2089x1764px. Fundus photo:
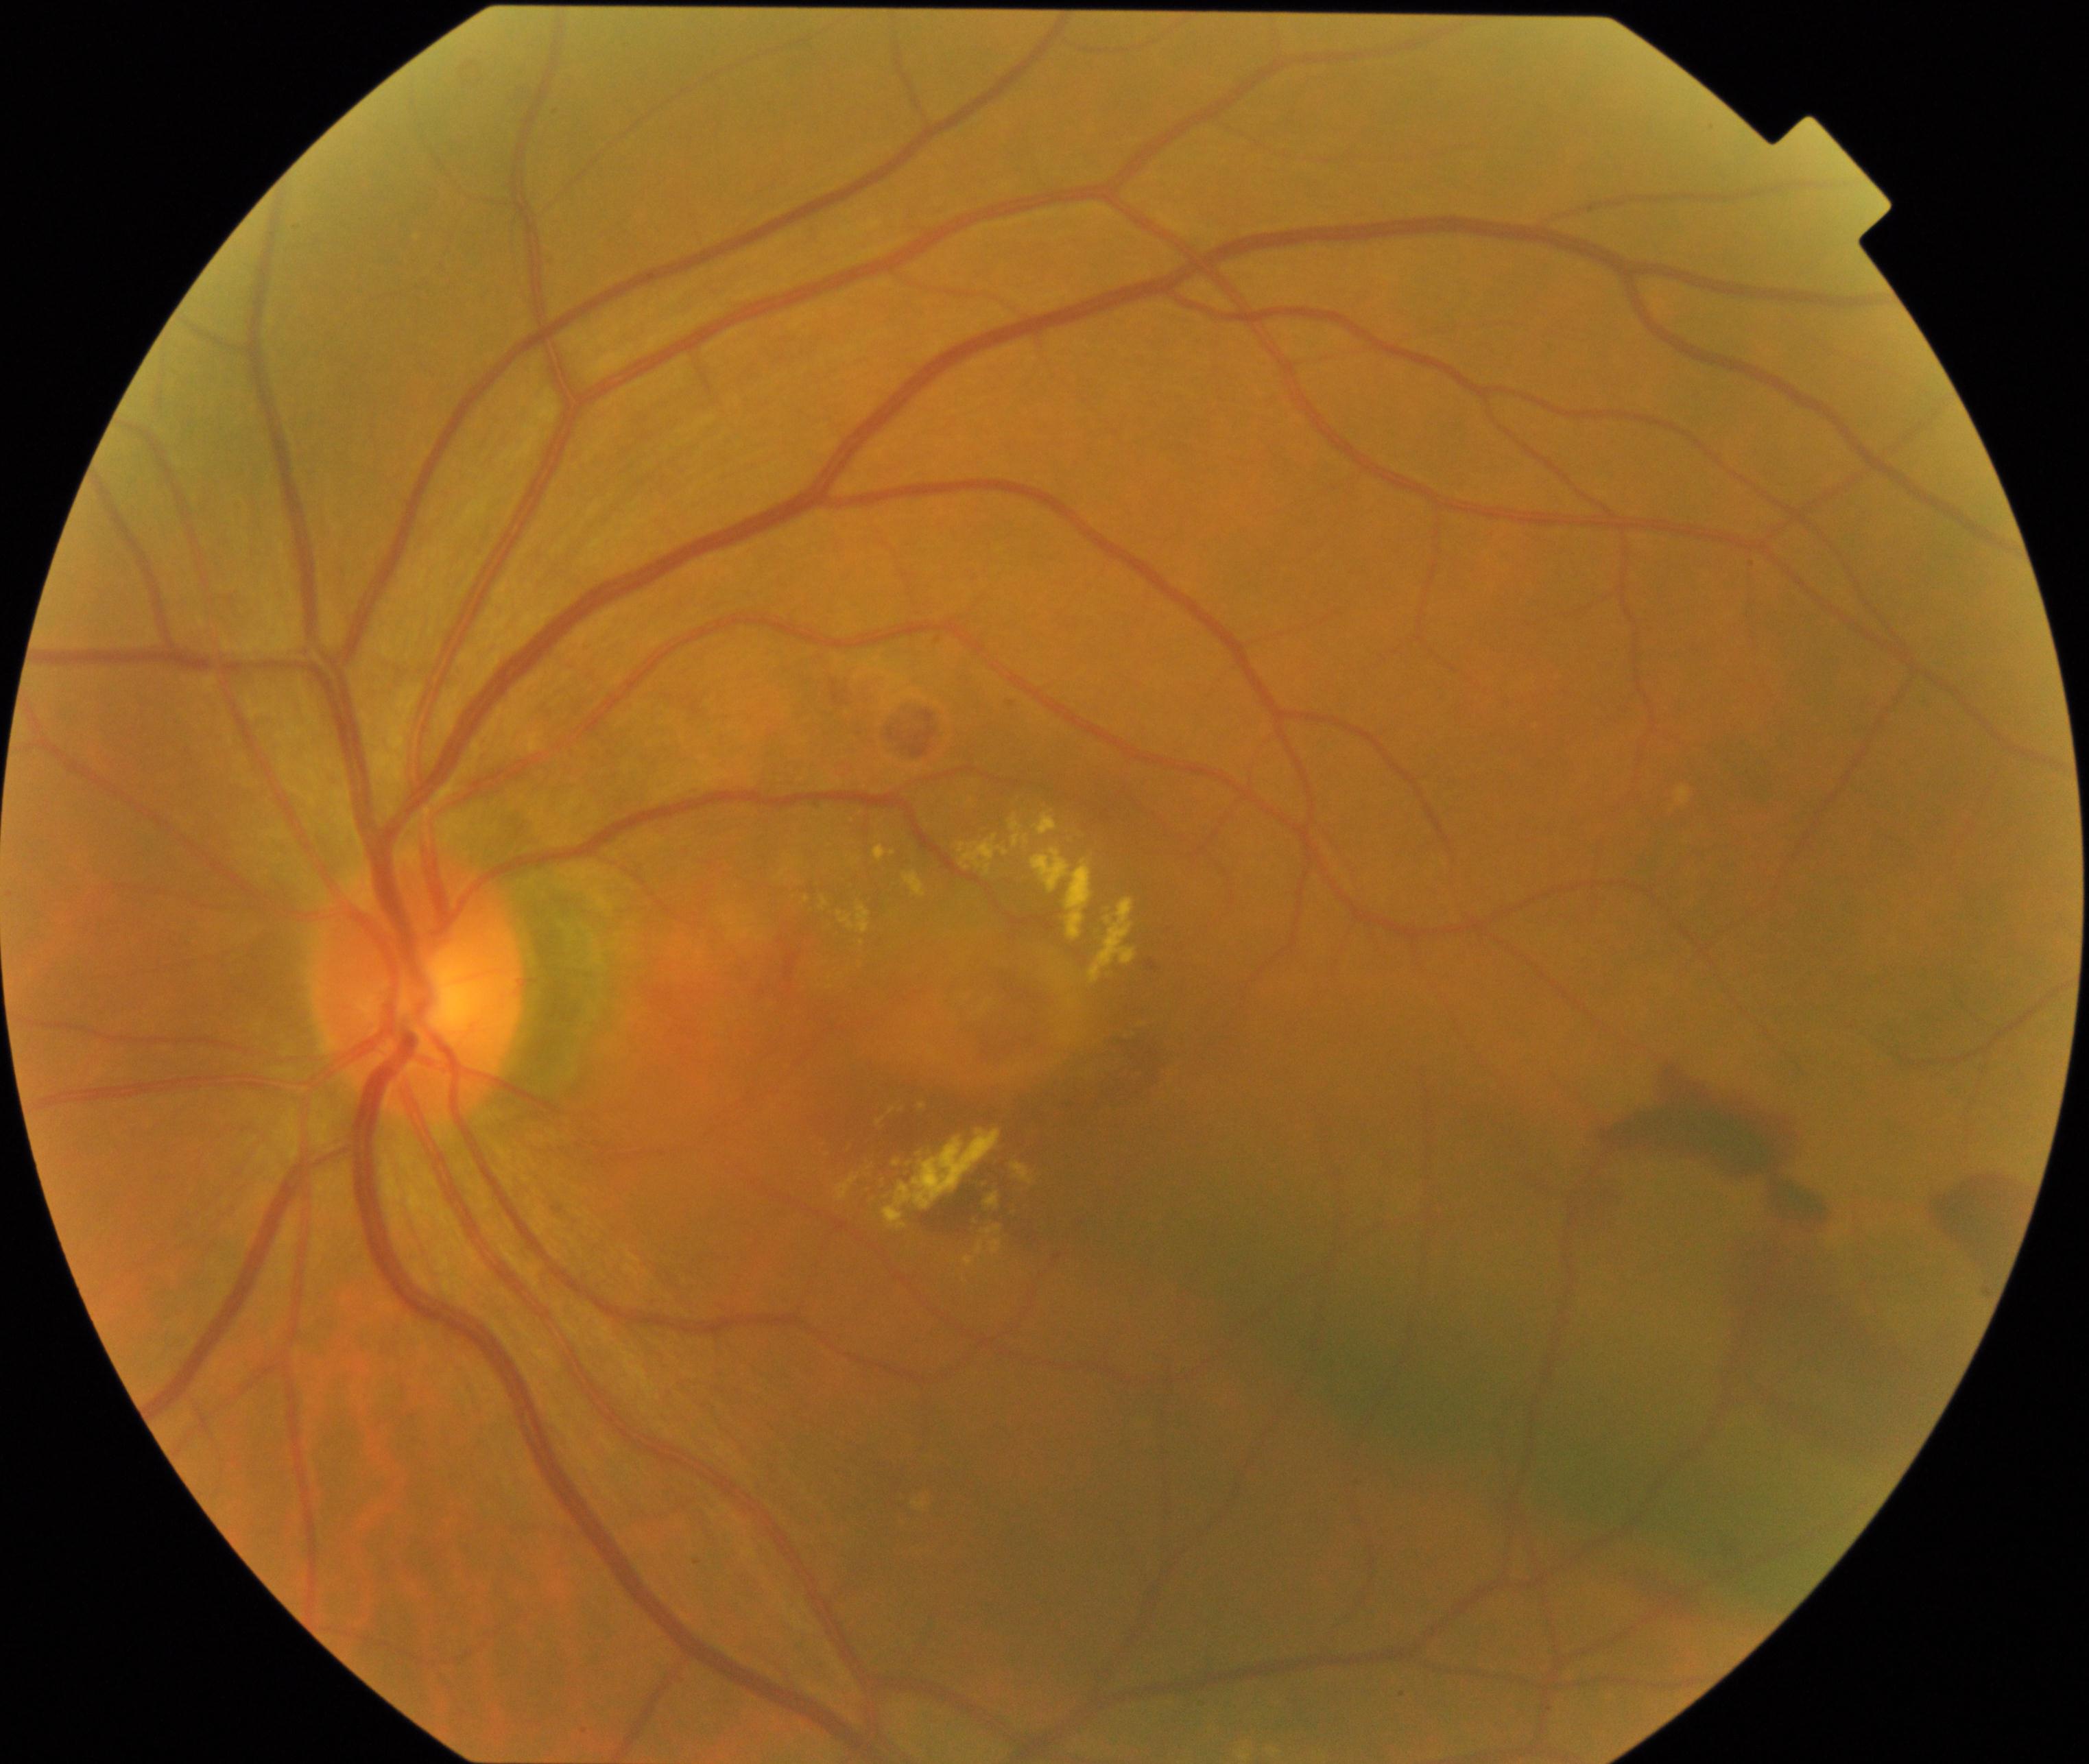
Impression: maculopathy. Characterized by lesions within the macular area, such as intermediate or neovascular age-related macular degeneration, retinal angiomatous proliferation, polypoidal choroidal vasculopathy, choroidal neovascularization, idiopathic macular telangiectasia, and macular atrophy, not caused by other listed disease categories.